240x240 · camera: Nidek AFC-330.
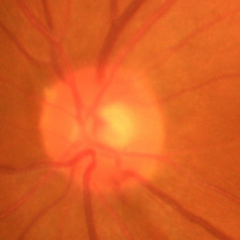
Early glaucomatous changes.